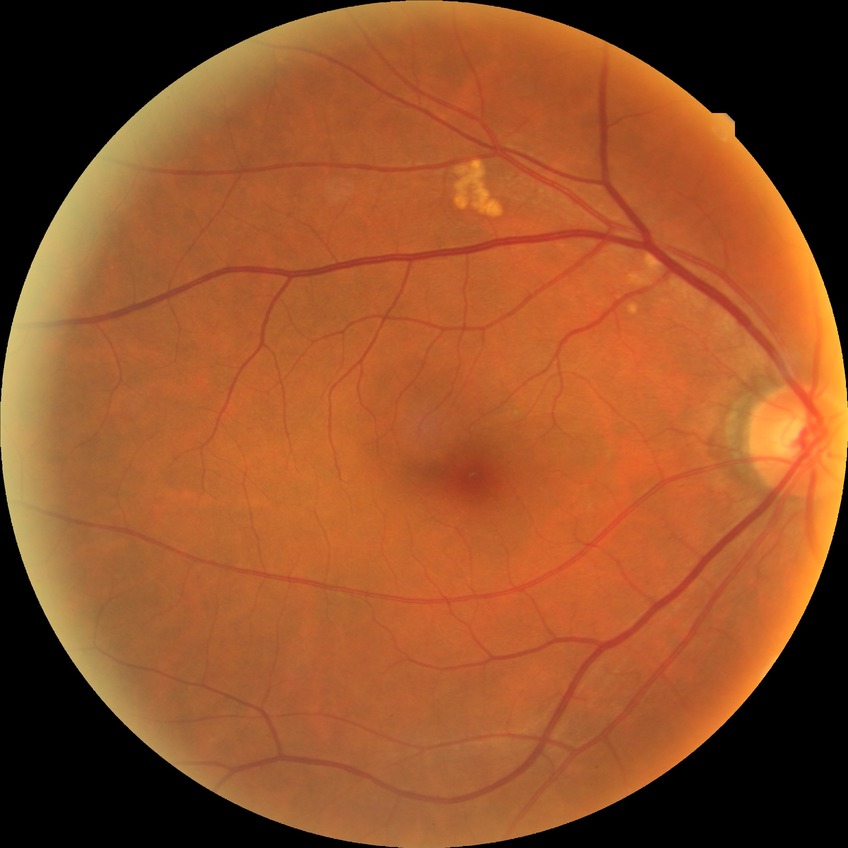

Diabetic retinopathy (DR): NDR (no diabetic retinopathy).